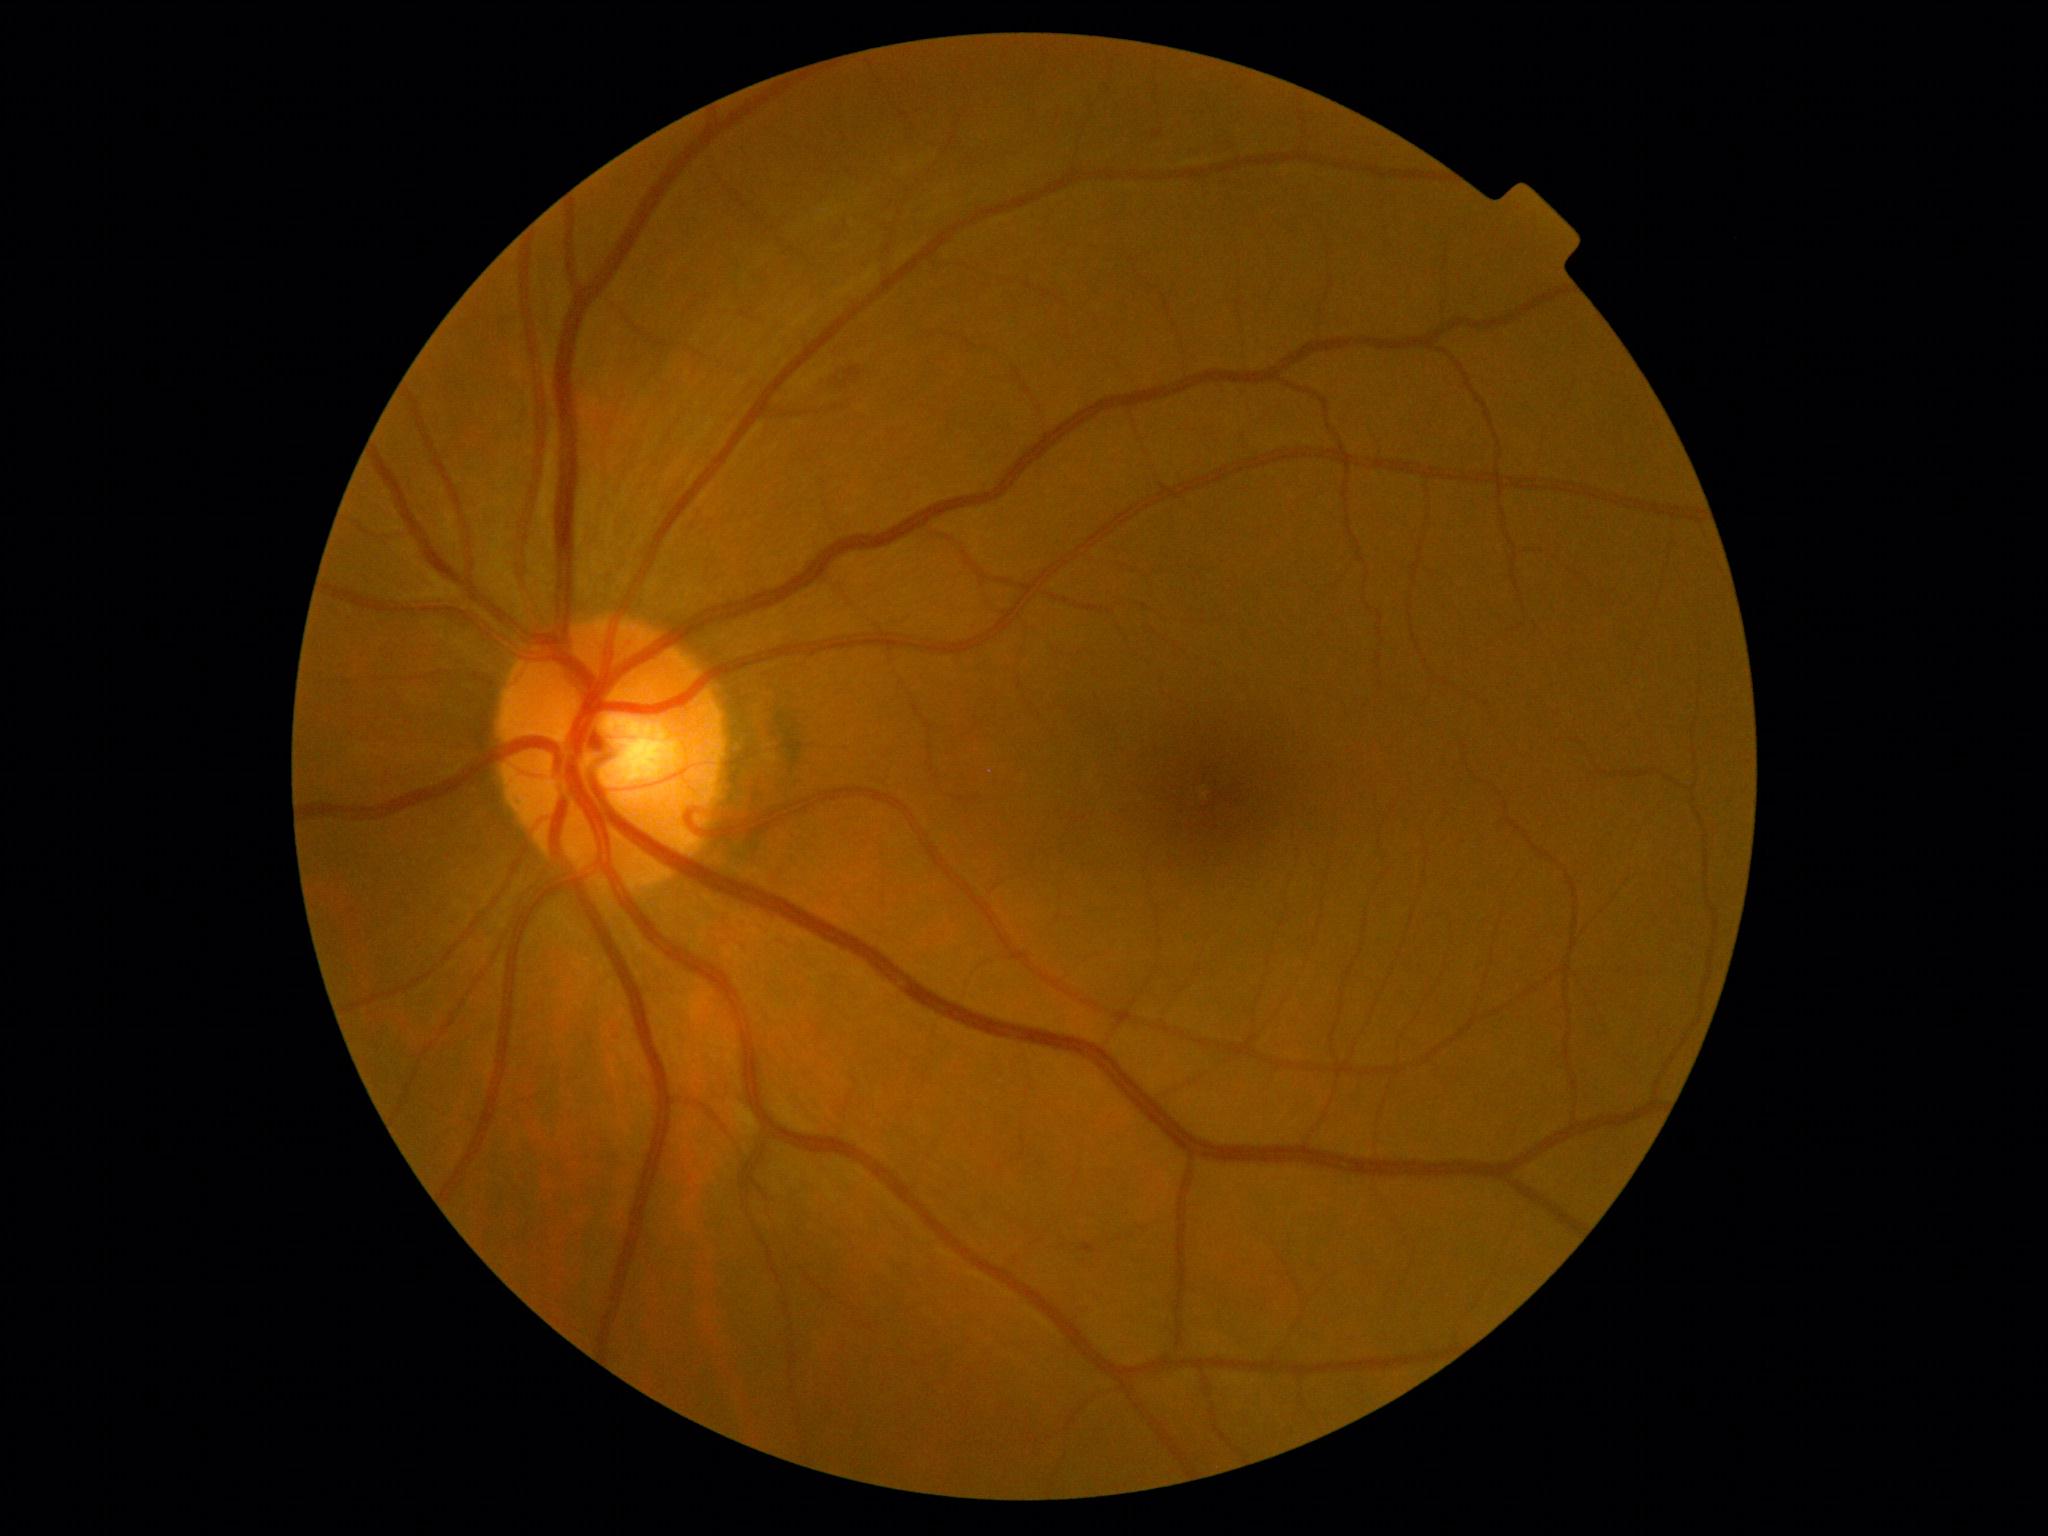 DR class: non-proliferative diabetic retinopathy. Retinopathy grade is 2.